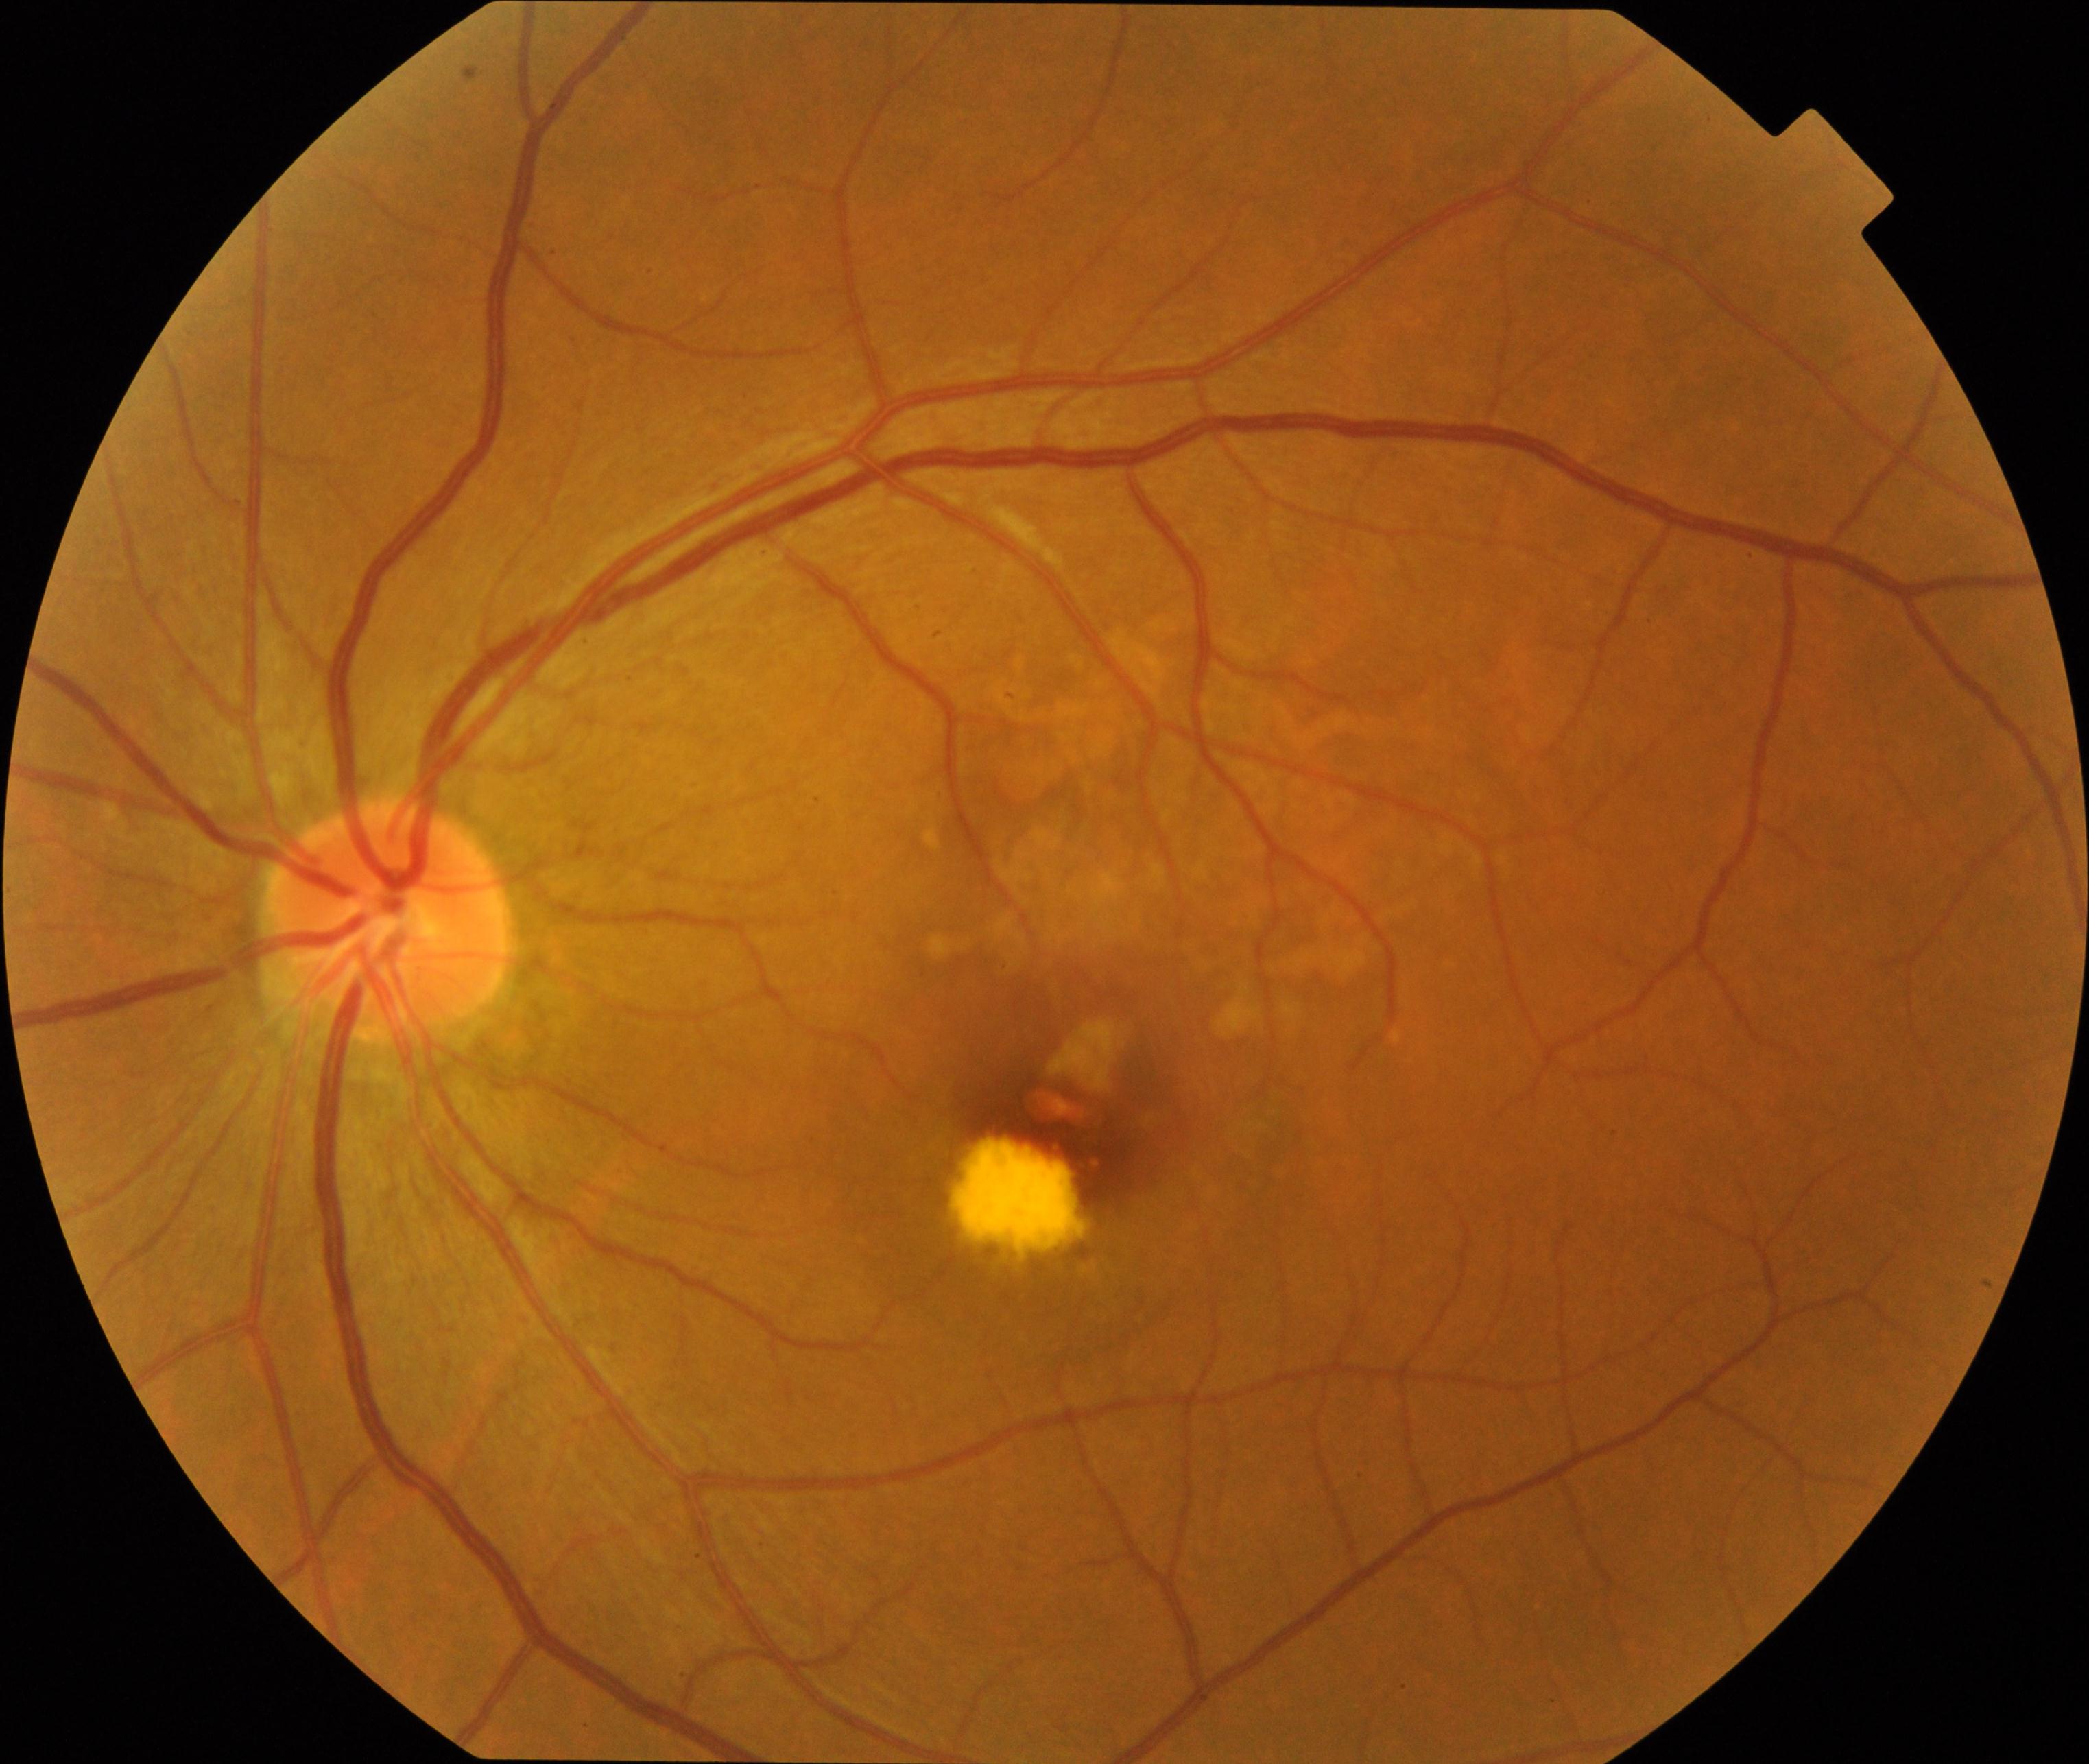
The image shows maculopathy. Typically showing lesions within the macular area, such as intermediate or neovascular age-related macular degeneration, retinal angiomatous proliferation, polypoidal choroidal vasculopathy, choroidal neovascularization, idiopathic macular telangiectasia, and macular atrophy, not caused by other listed disease categories.